Wide-field fundus photograph from neonatal ROP screening
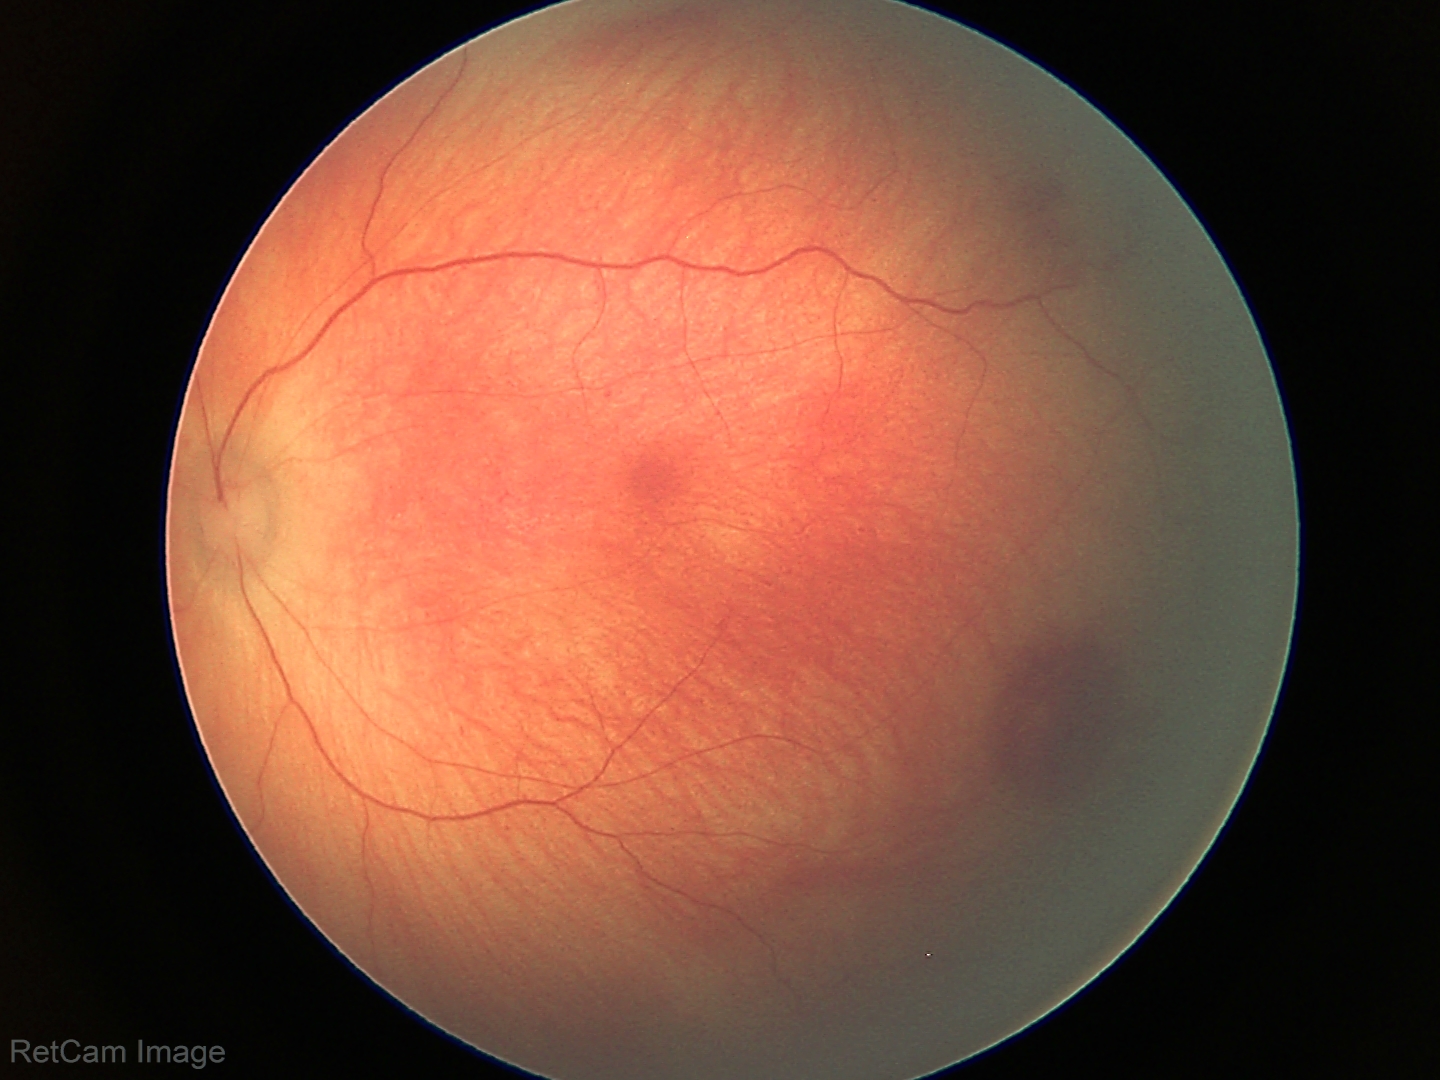 Q: What is the diagnosis from this examination?
A: retinal hemorrhages